FOV: 45 degrees. Color fundus image — 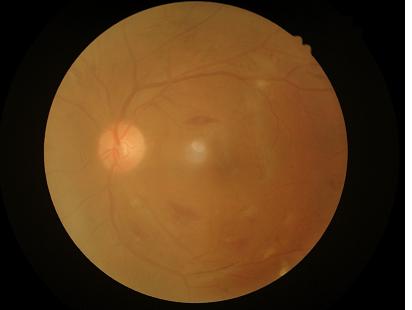
Even illumination with no color cast. Image quality is suboptimal. Reduced sharpness with visible blur. Narrow intensity range; structures are hard to distinguish.